Fundus photograph cropped around the optic nerve head. Captured on a Topcon TRC retinal camera. Mydriatic — 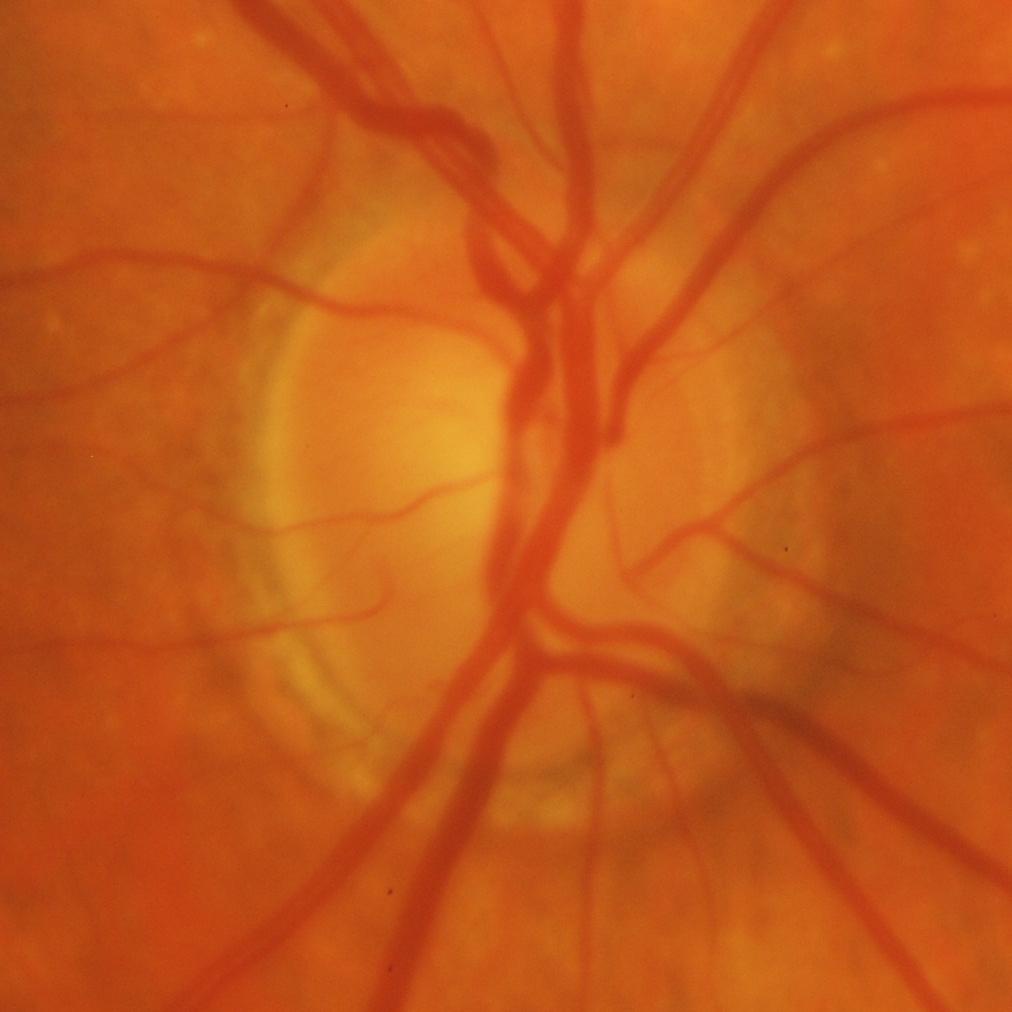

Glaucomatous findings.